Captured on a Nidek AFC-330 fundus camera:
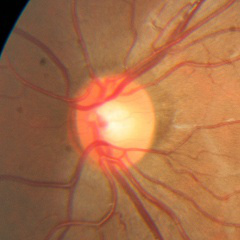
Assessment: no glaucomatous changes.